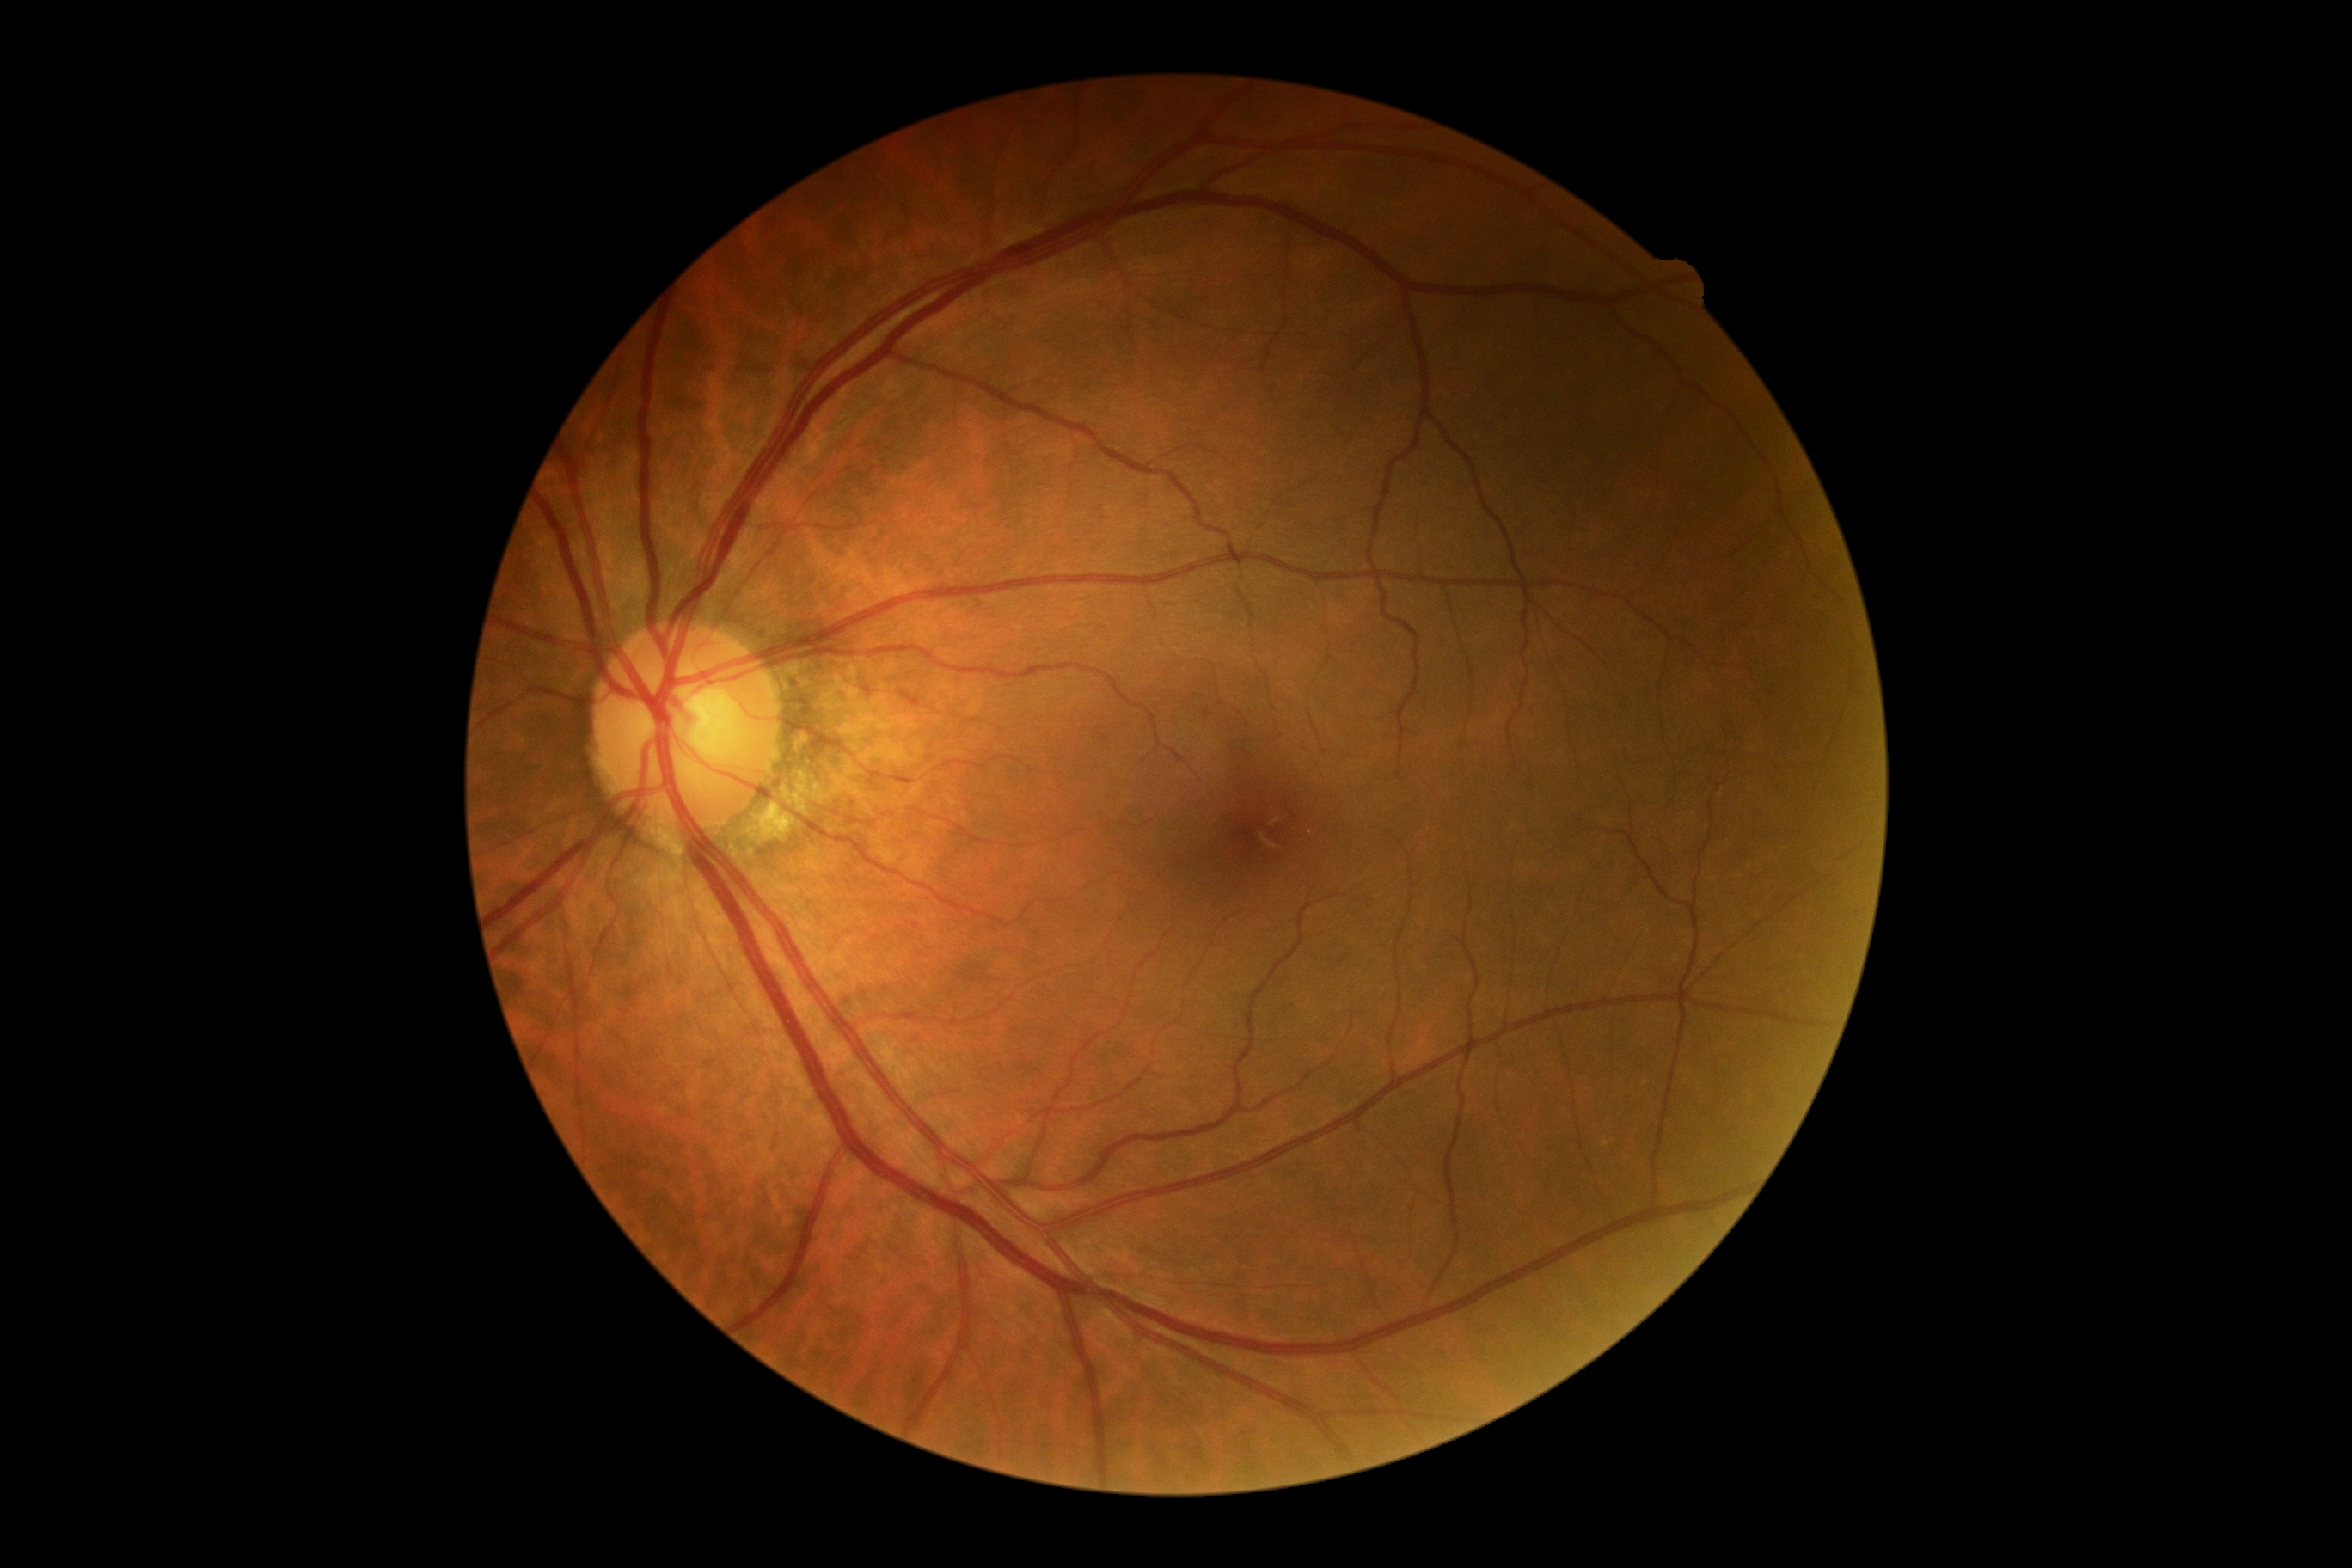 DR severity is no apparent retinopathy (grade 0). No signs of diabetic retinopathy.